Pediatric retinal photograph (wide-field) · 1440x1080px · Natus RetCam Envision, 130° FOV
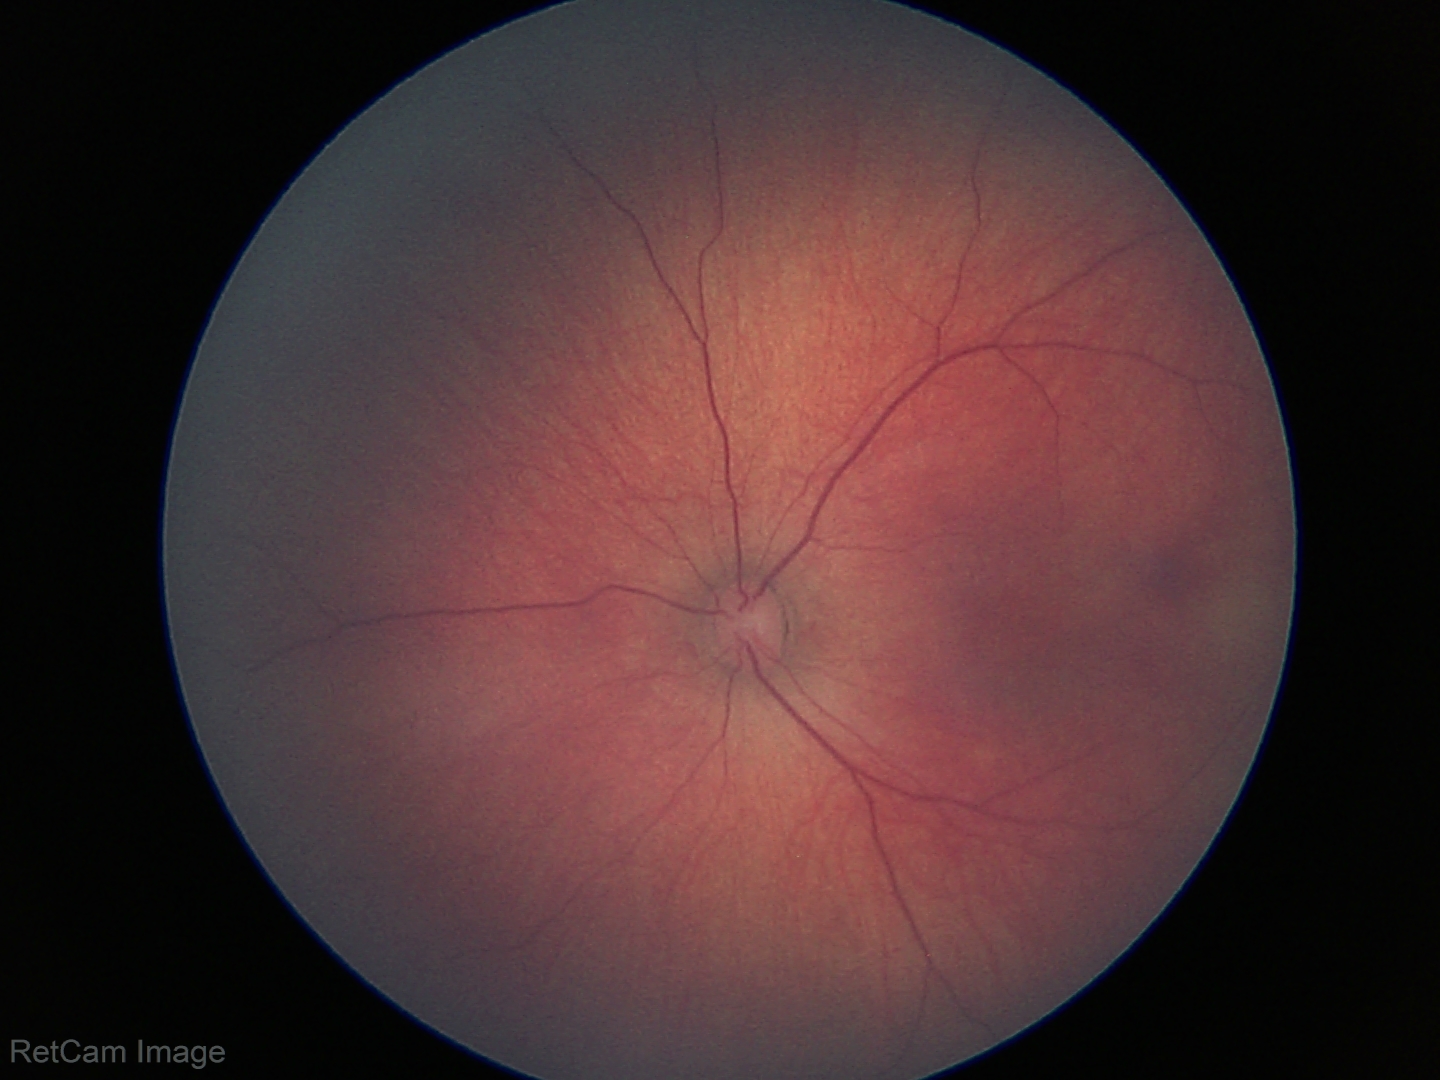
Screening examination diagnosed as physiological.